45° field of view: 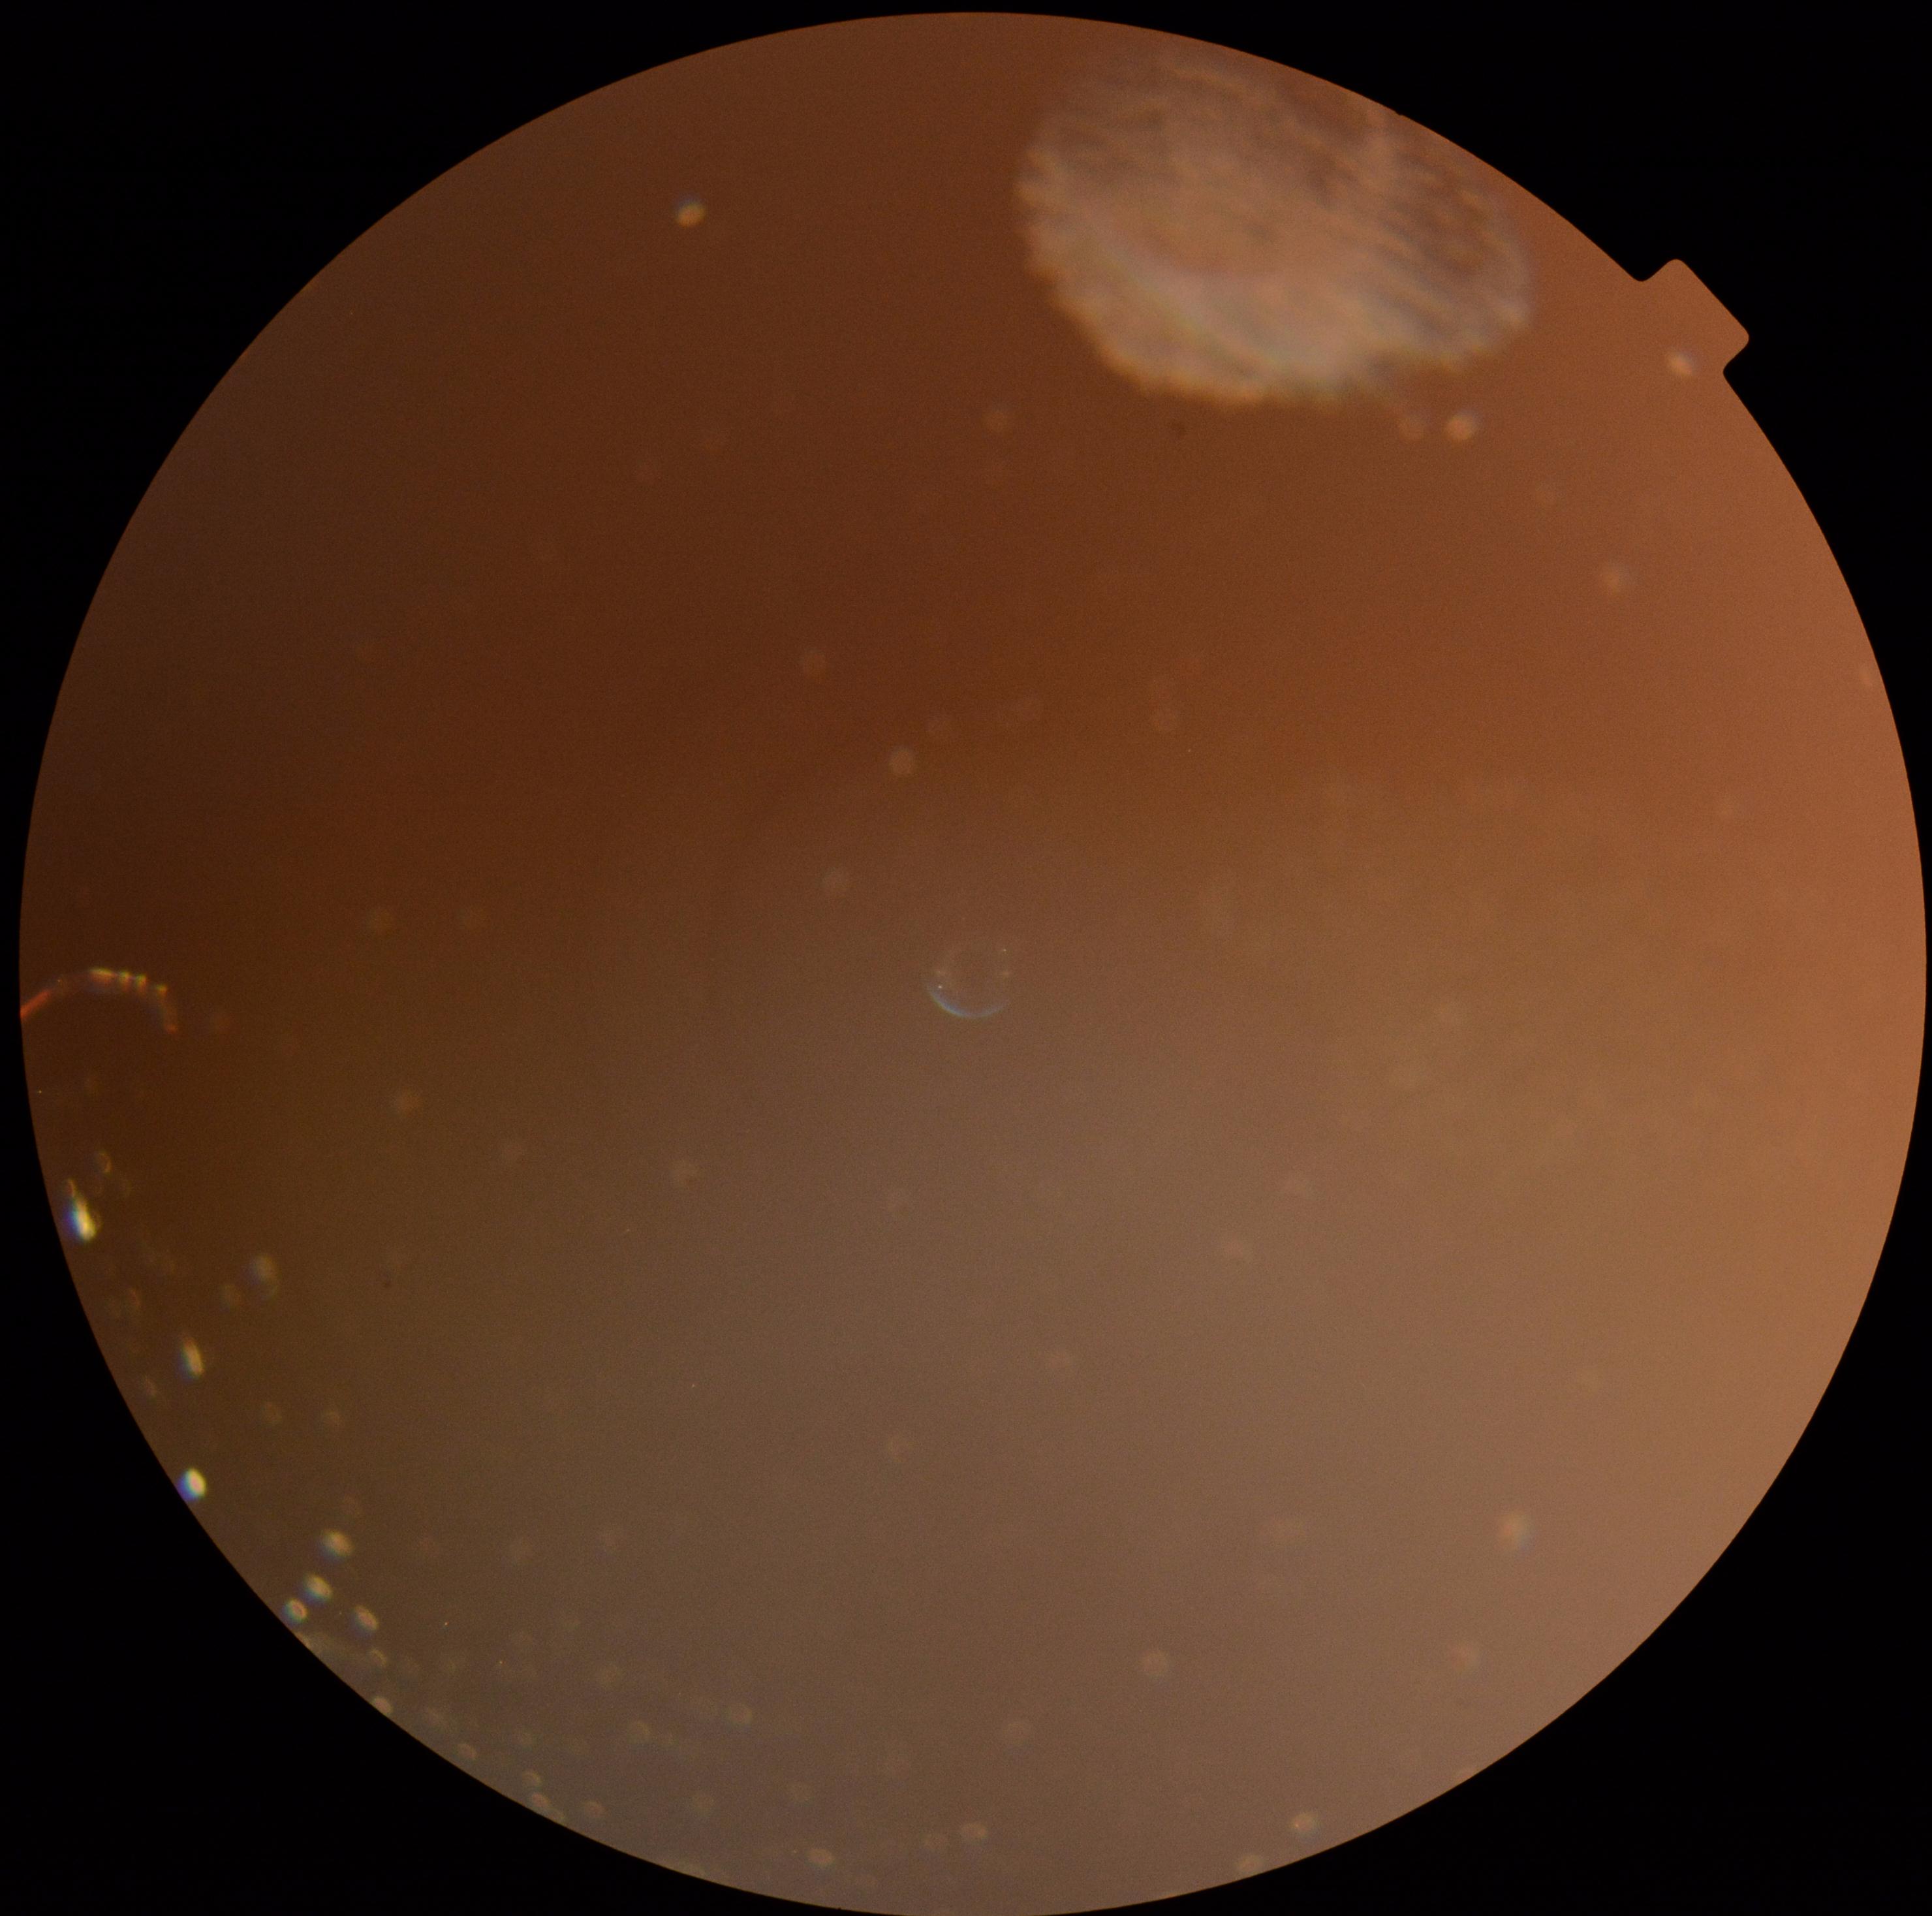
Annotations:
* DR: ungradable
* image quality: below grading threshold